45° FOV — 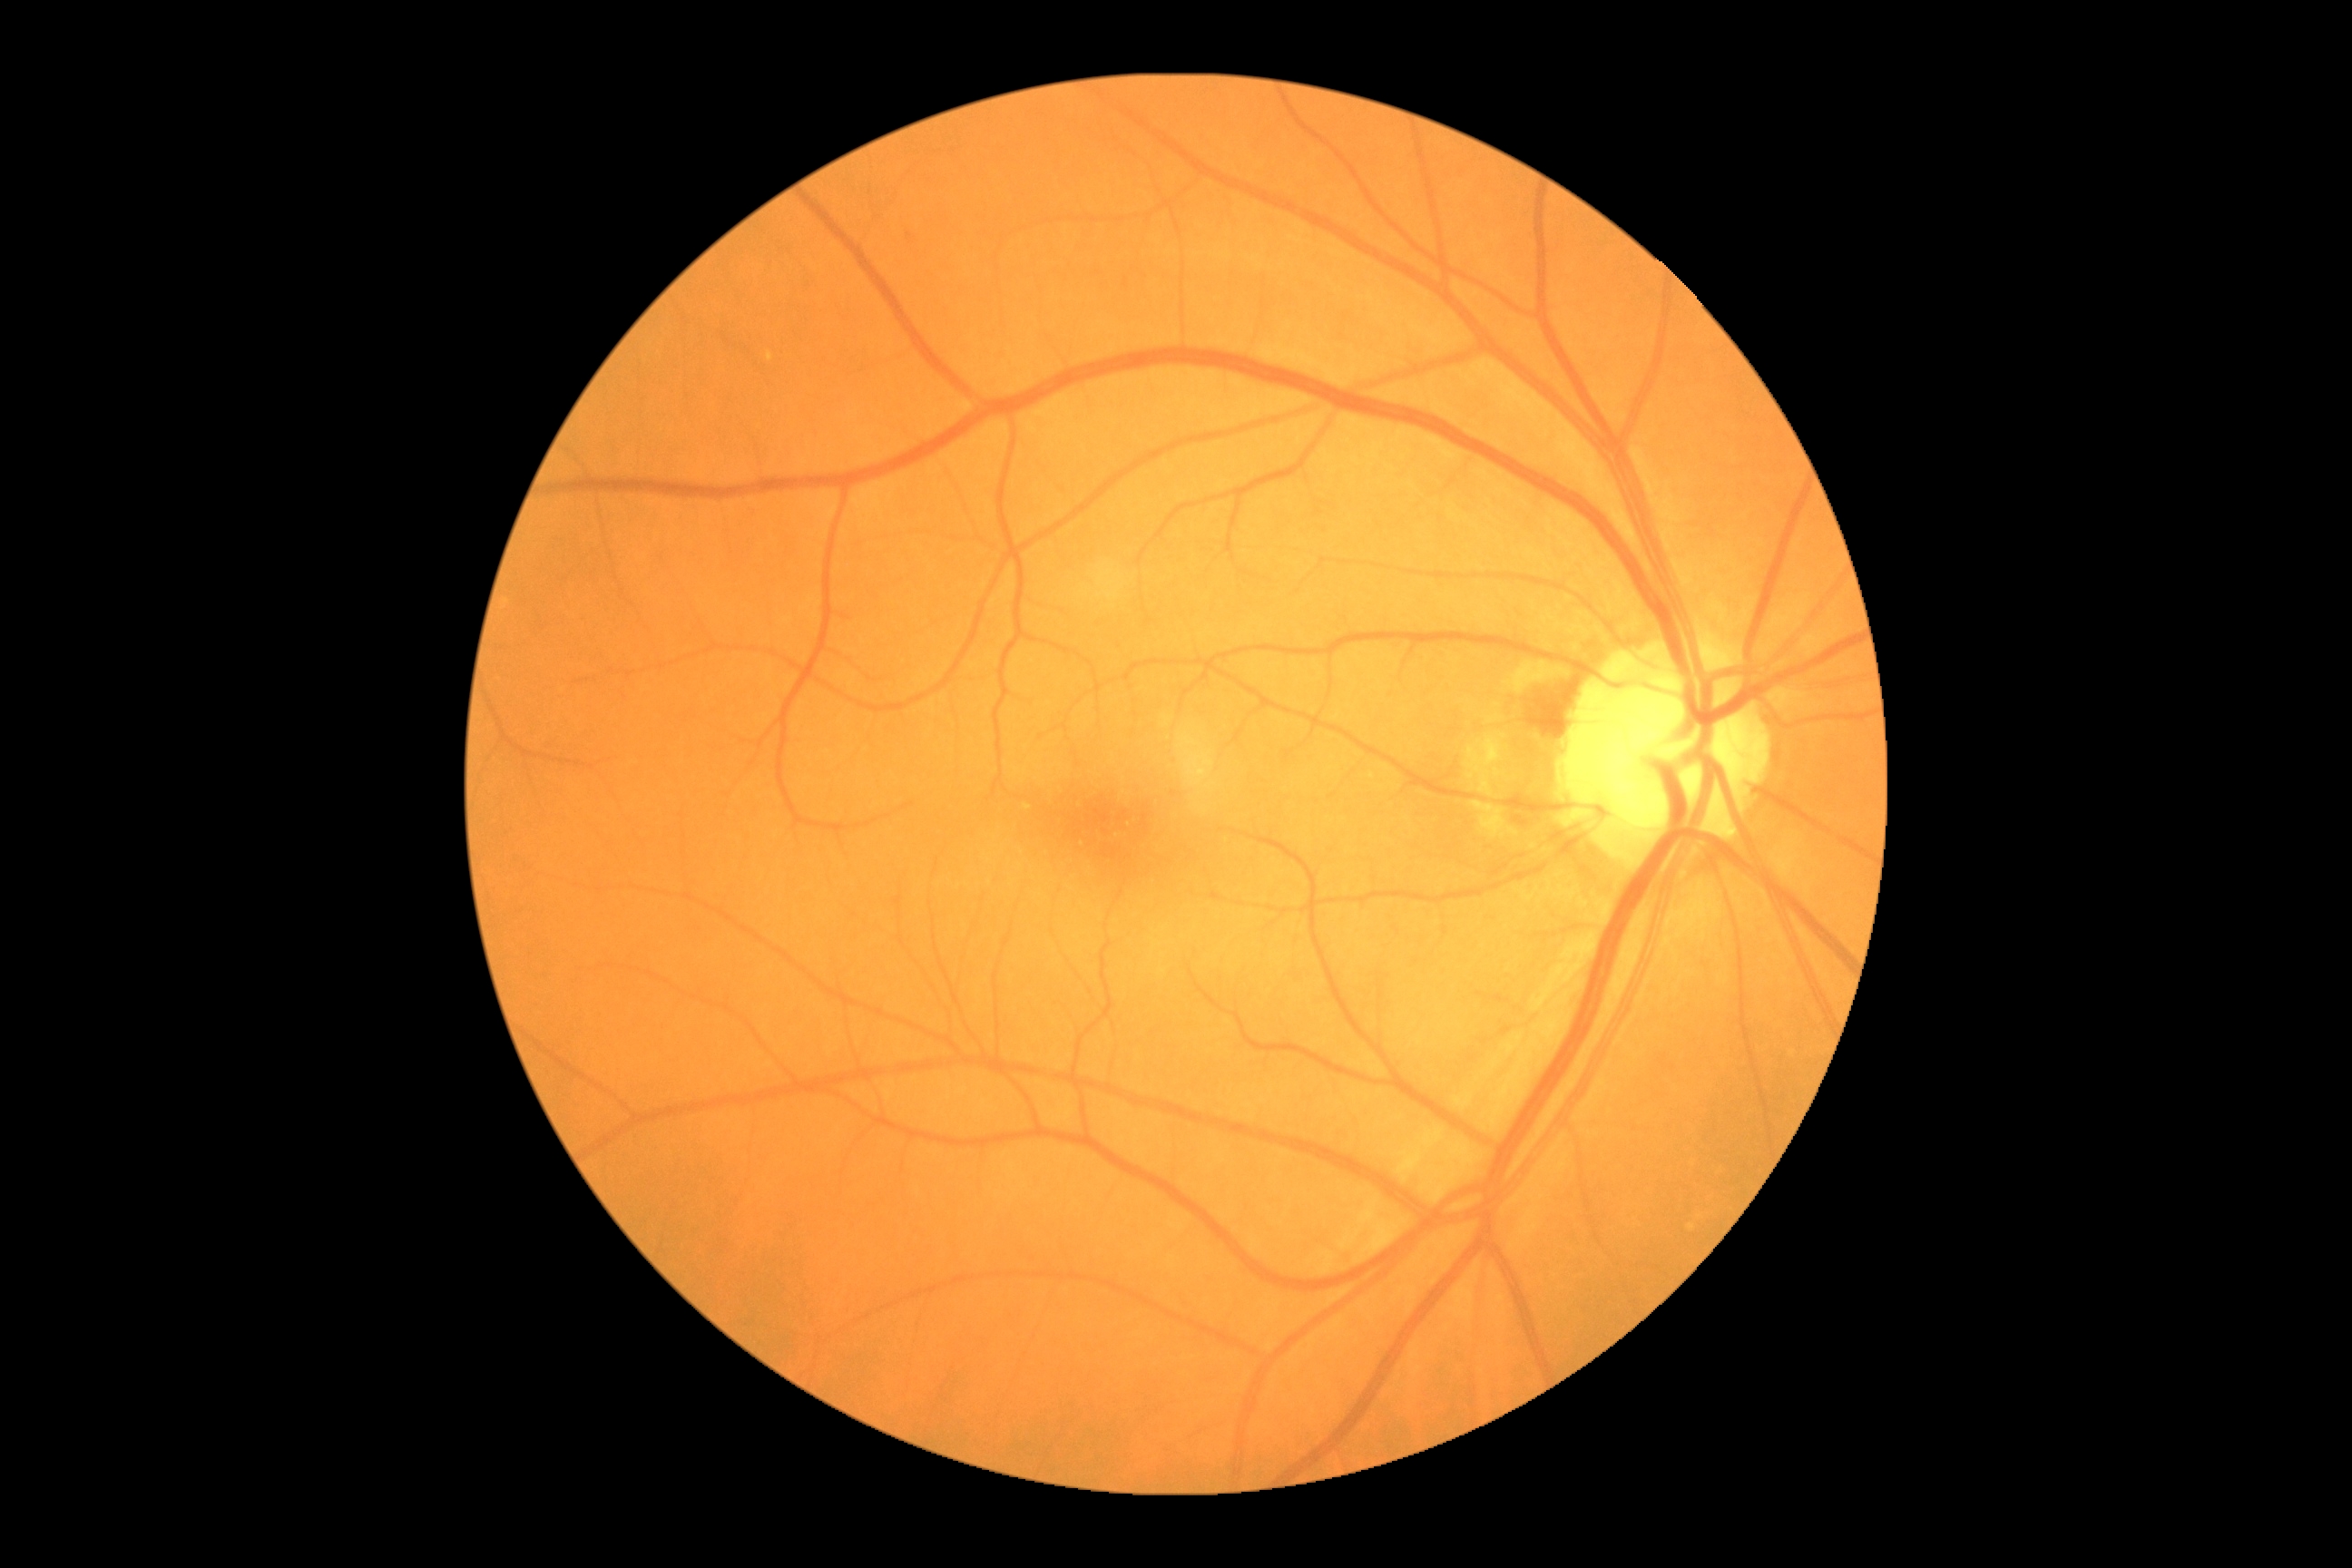

Diabetic retinopathy: 0.